Infant wide-field fundus photograph. Captured with the Phoenix ICON (100° field of view)
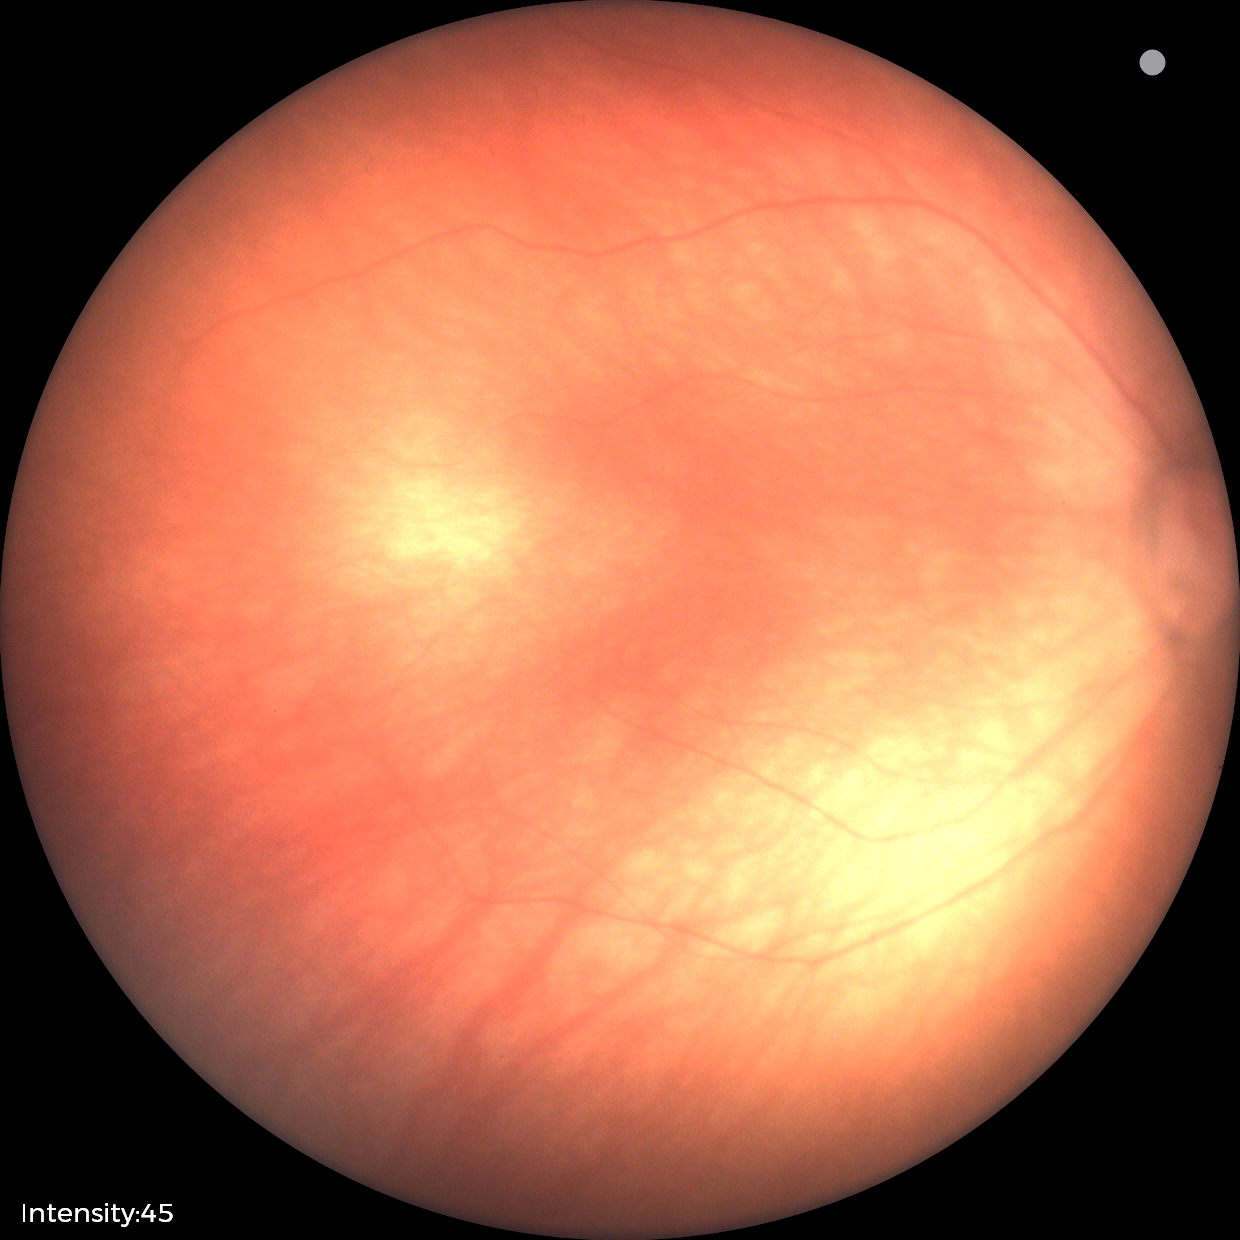

Screening diagnosis: physiological finding.